Image size 1240x1240; 100° field of view (Phoenix ICON); wide-field fundus photograph of an infant.
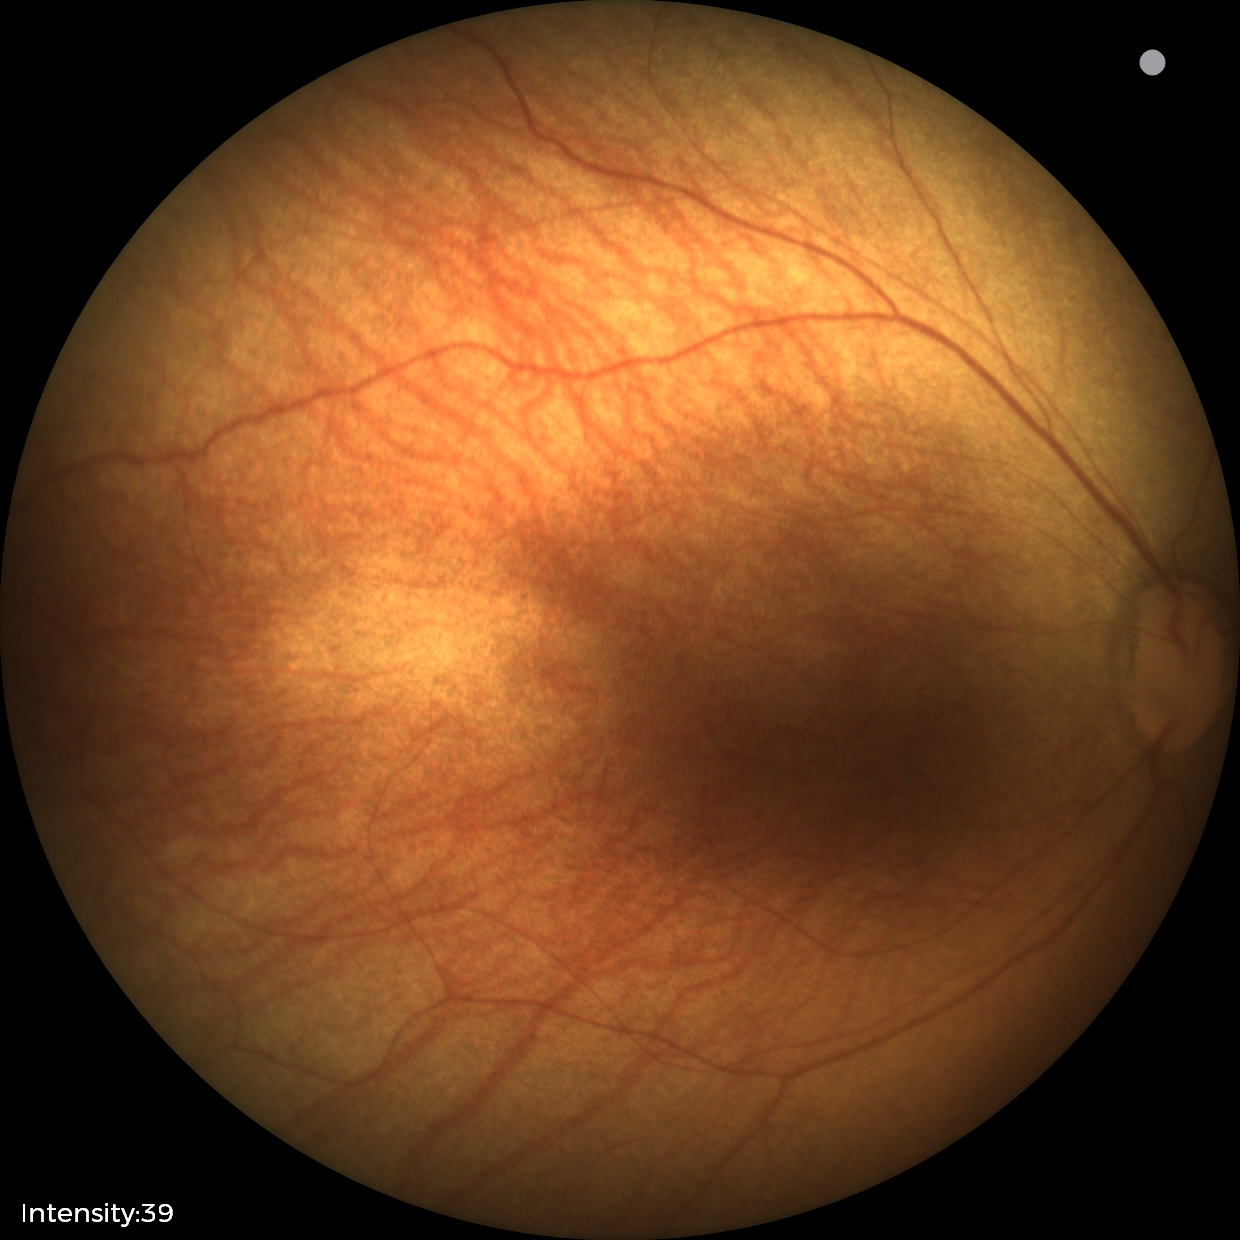

Assessment: no abnormal retinal findings.